Graded on the modified Davis scale — 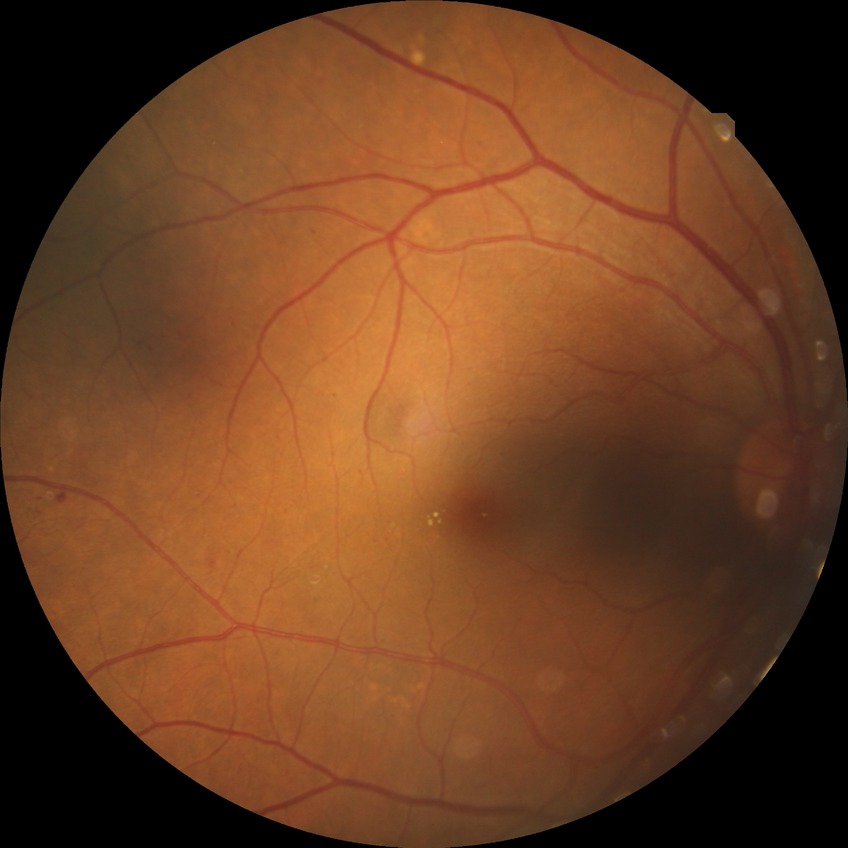
DR severity is SDR.